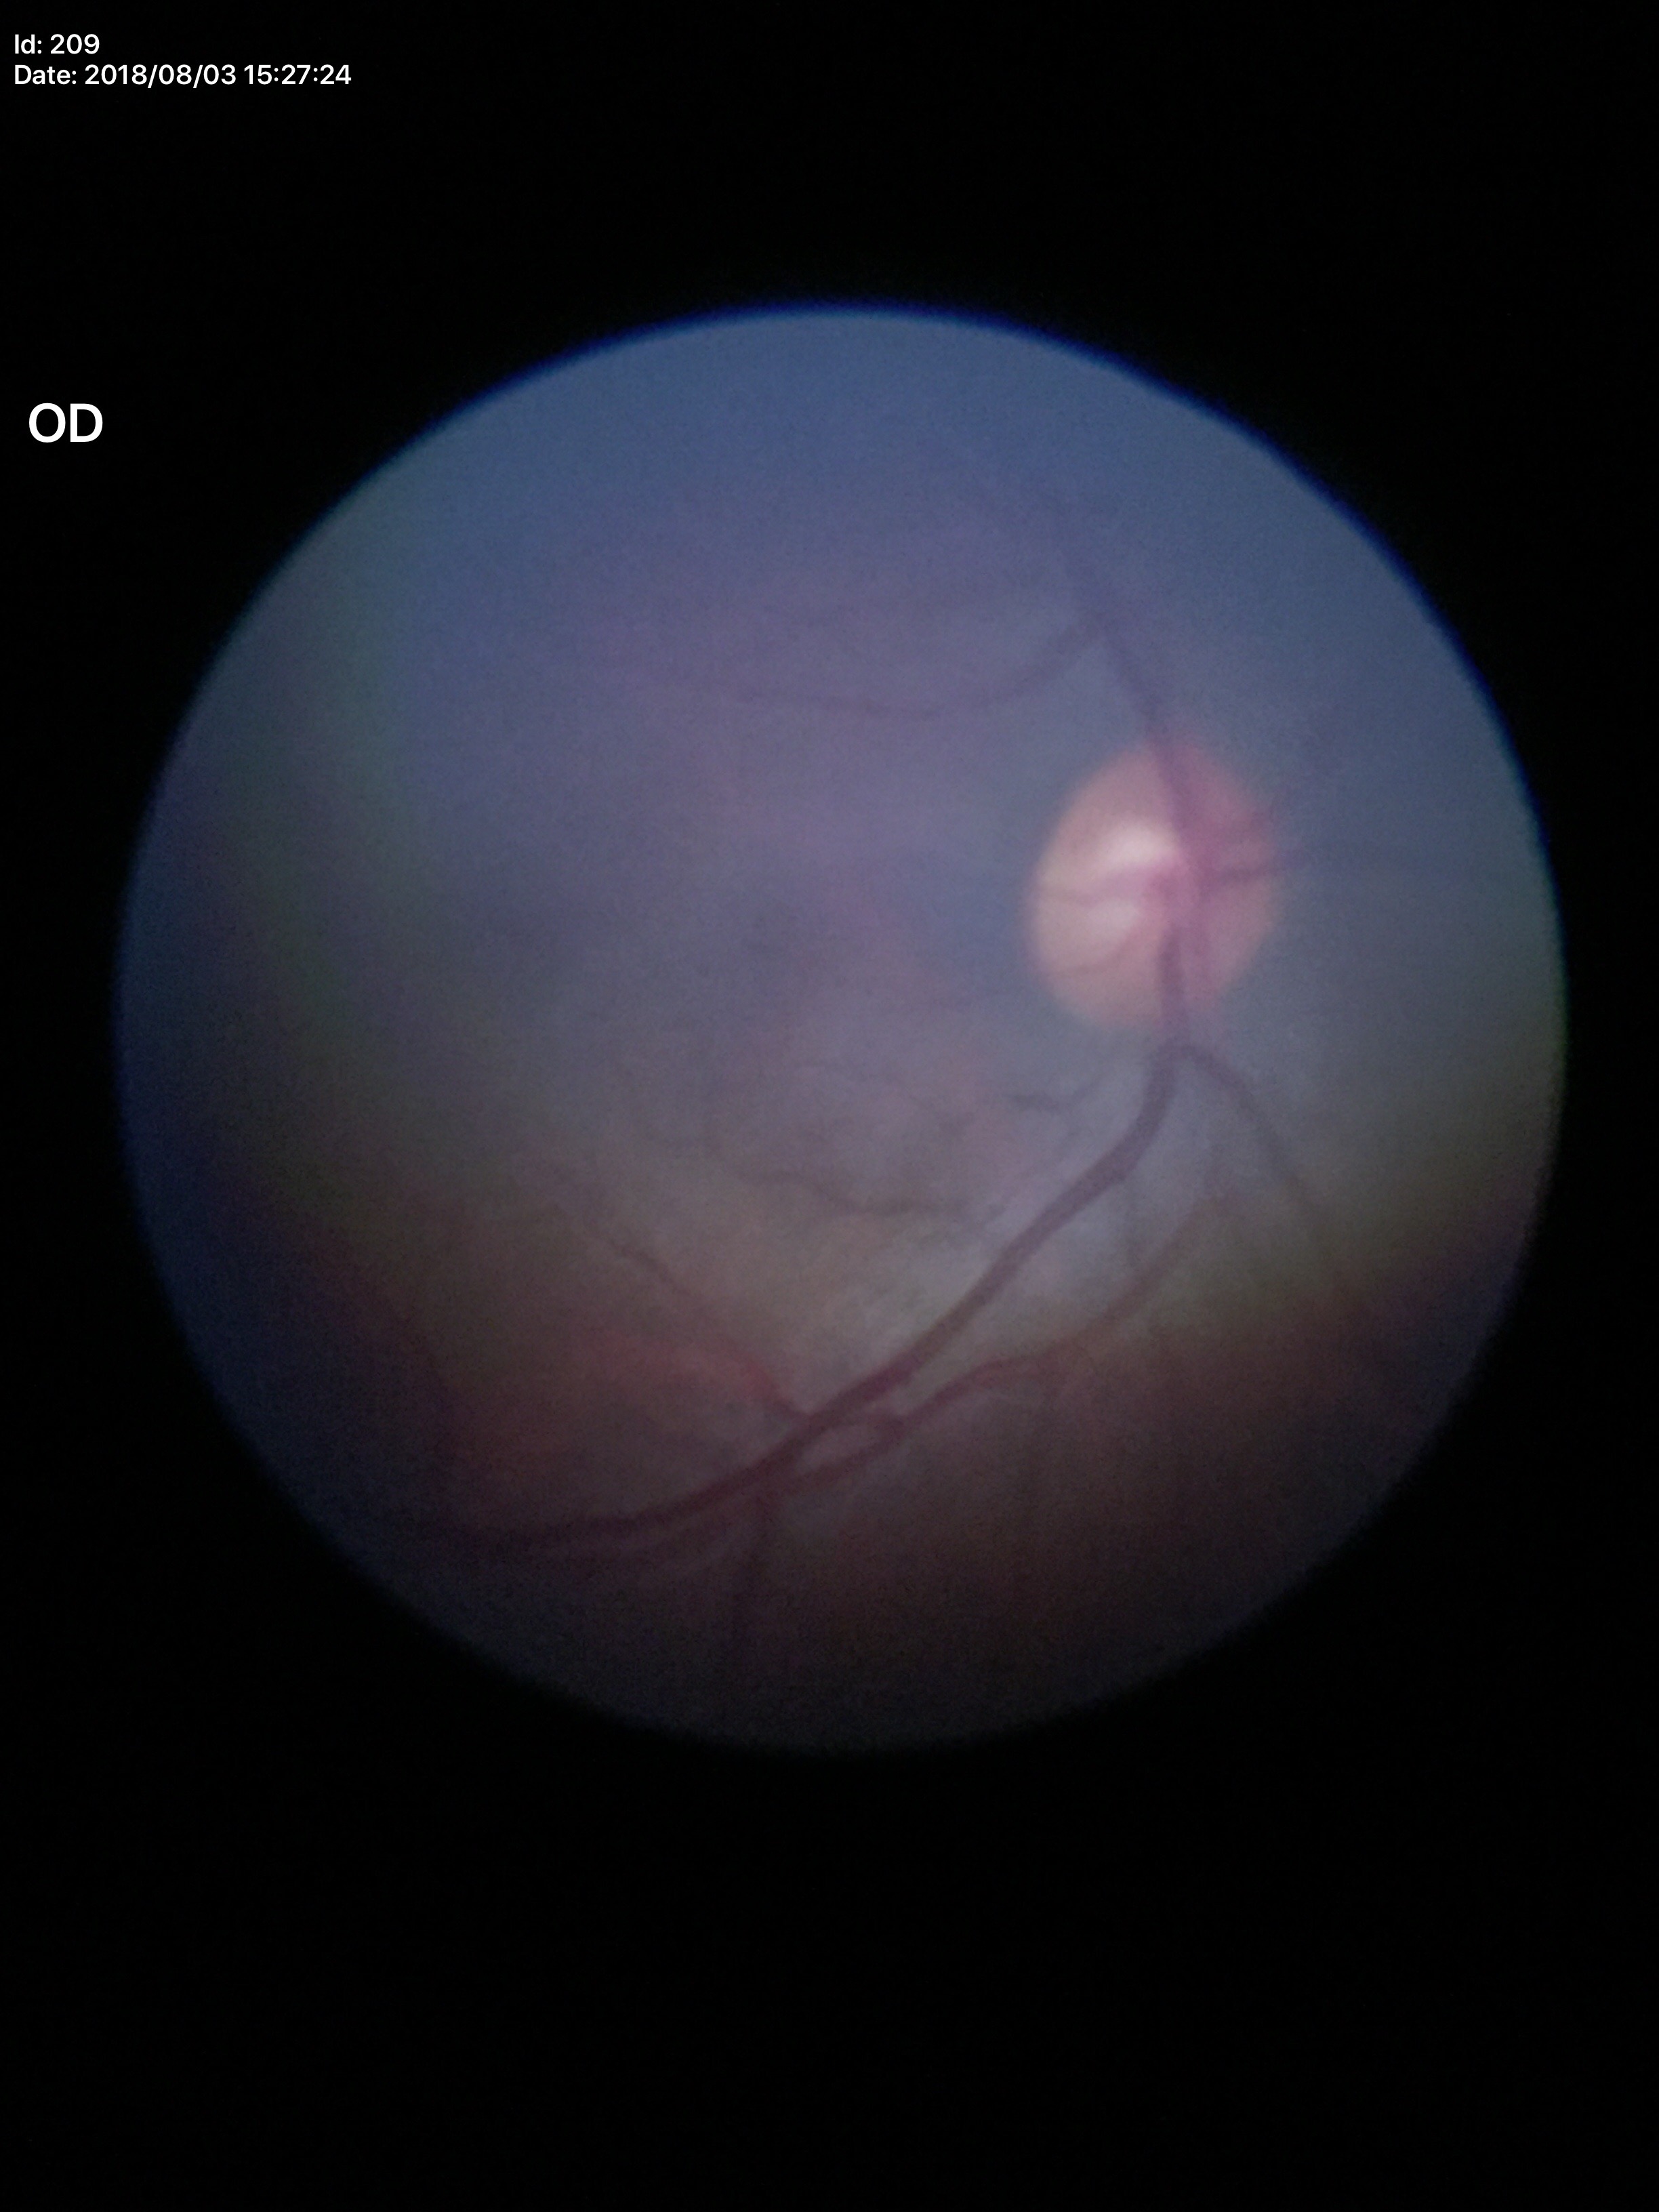

Q: Glaucoma screening result?
A: no suspicious findings
Q: What is the VCDR?
A: 0.53